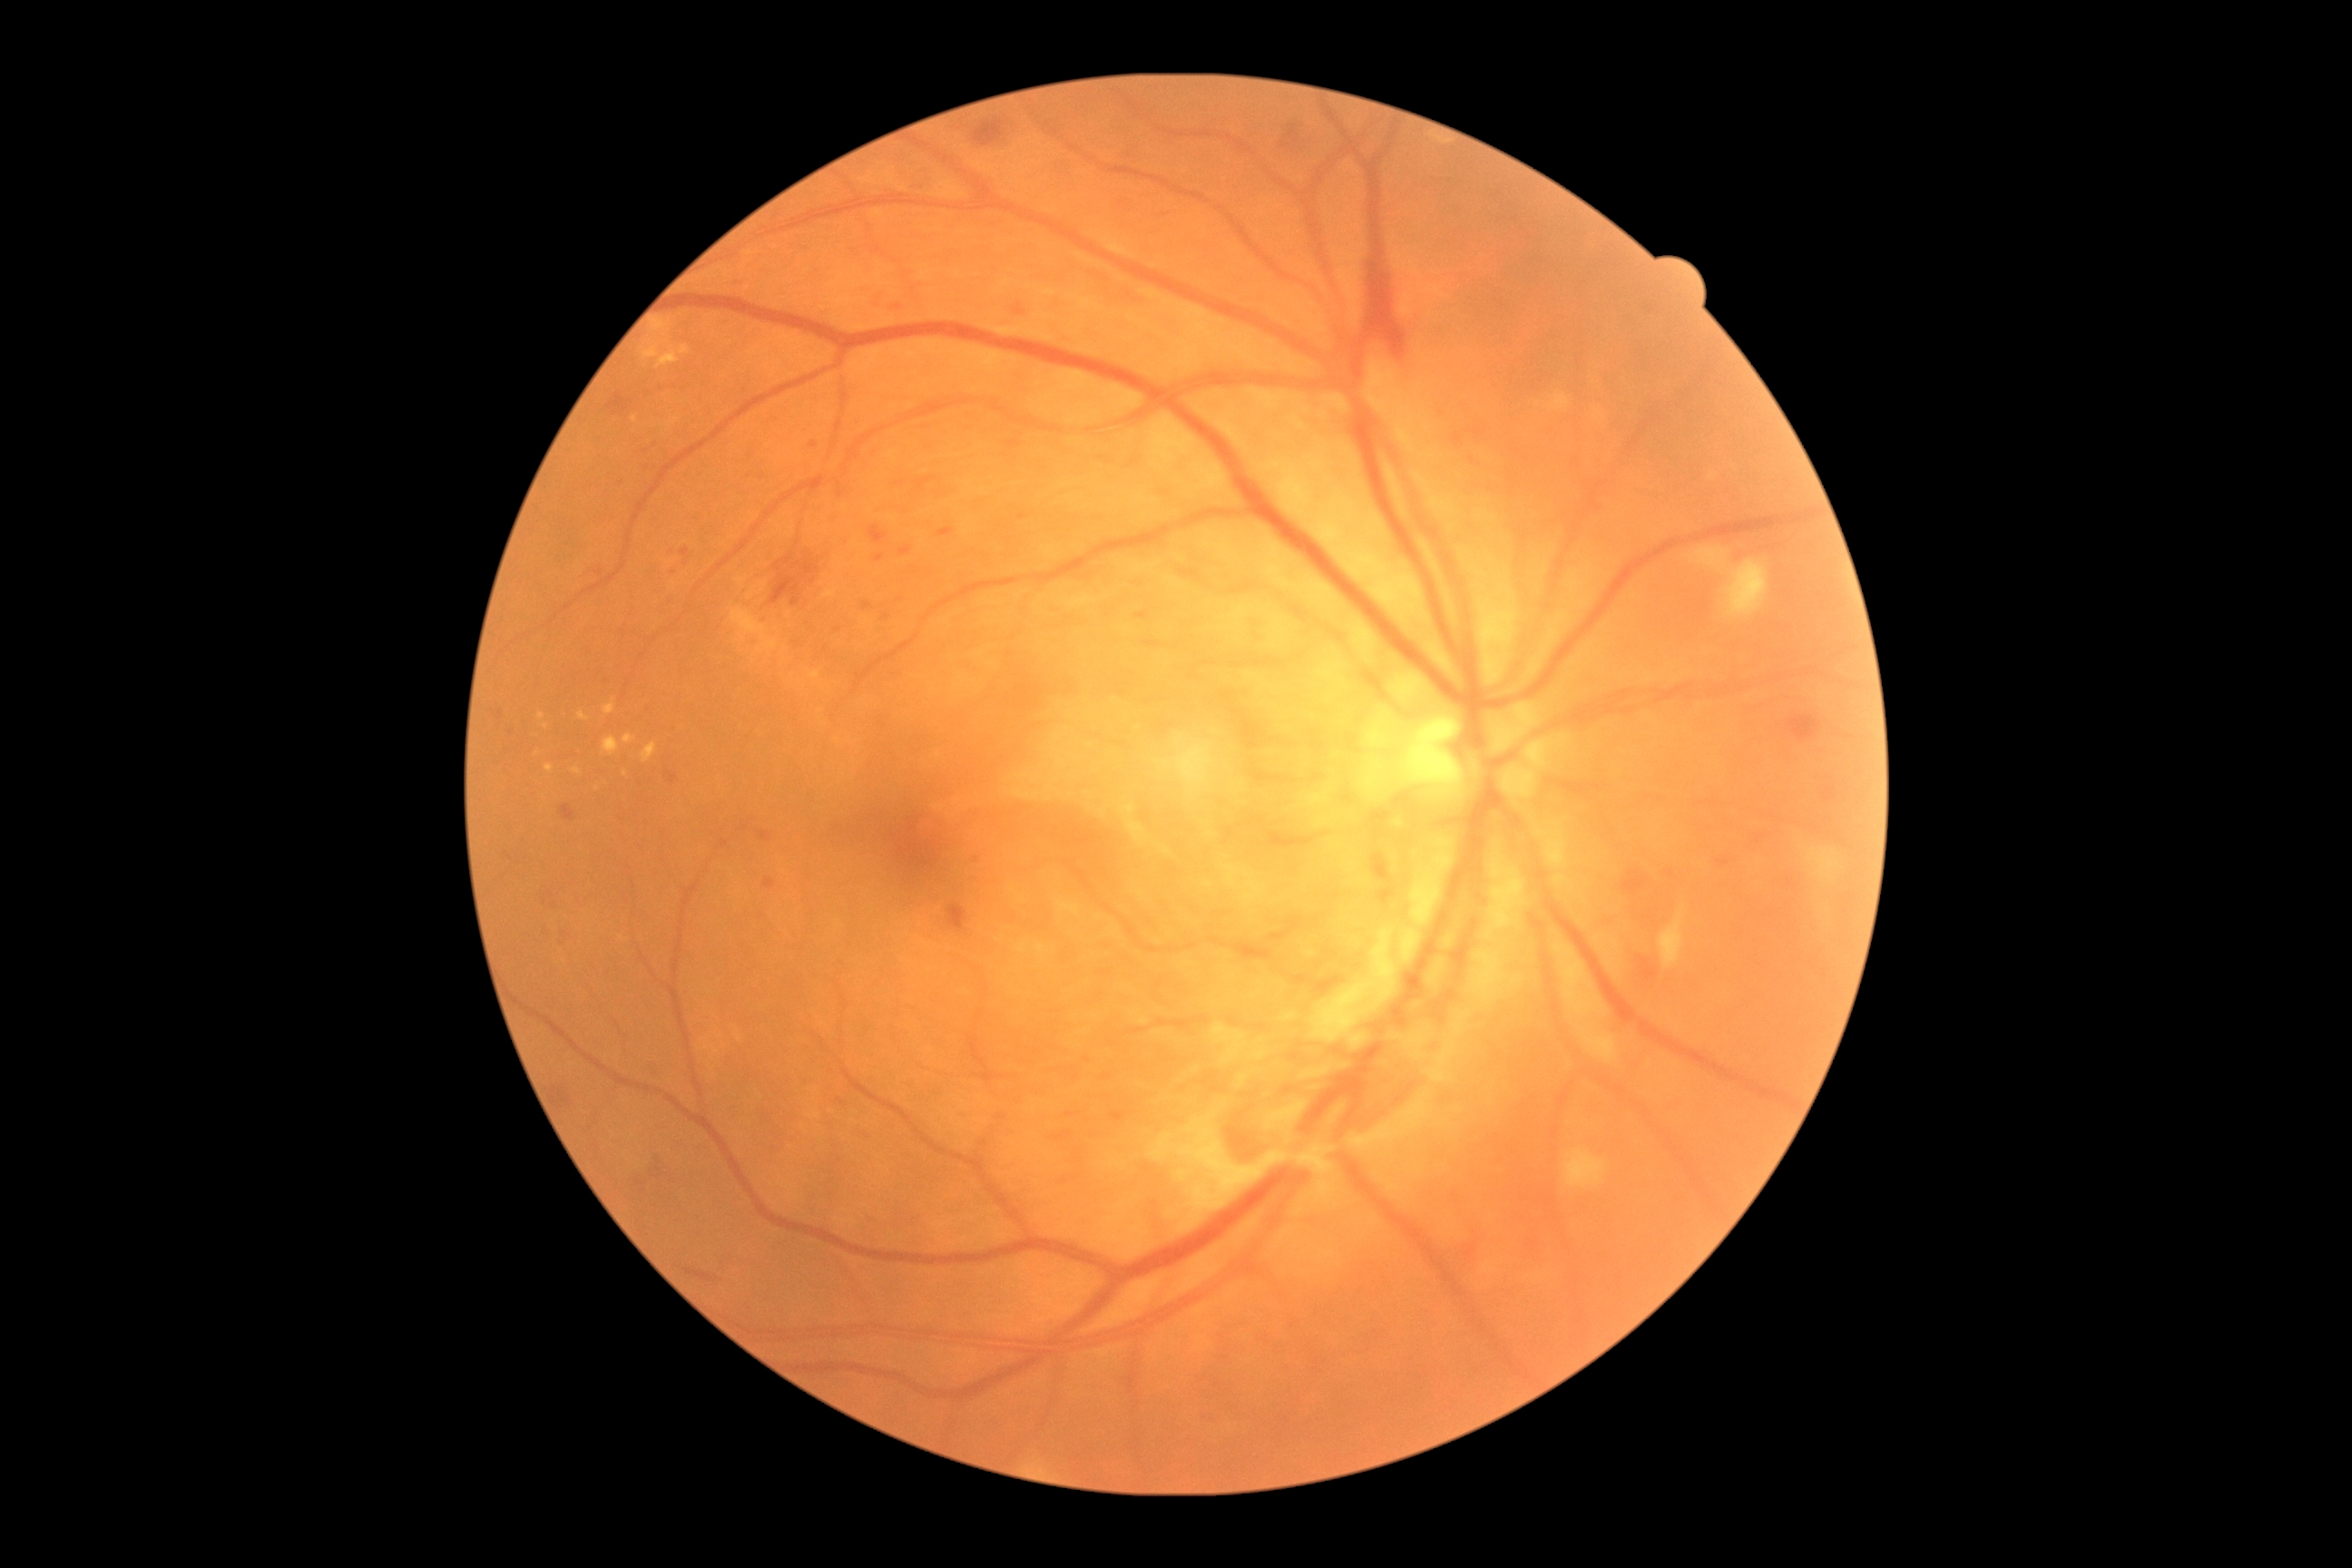

Diabetic retinopathy grade: 4 (PDR).
Soft exudates located at (1660,905,1685,968); (1565,1148,1607,1190); (1554,934,1607,1023); (1578,1023,1620,1064); (1723,560,1769,618); (1807,848,1839,881); (732,609,779,651).
Hemorrhages are present, including at (607,395,634,416); (1063,816,1112,852); (683,1268,720,1282); (1315,977,1342,995); (1366,273,1409,364); (1787,877,1798,890); (1378,890,1393,905); (946,903,968,936); (1462,1239,1480,1260); (1787,712,1823,743); (560,805,576,821); (1291,975,1313,986); (665,770,678,783).
Microaneurysms are present, including at (899,547,912,556); (883,614,890,622); (1017,306,1024,317); (1754,836,1769,845); (1135,612,1150,622); (1066,1112,1079,1119); (1220,691,1275,752); (937,527,954,538); (836,1099,847,1106).
Smaller microaneurysms around [639,1182]; [511,732]; [1472,461]; [644,1191]; [898,307]; [555,905]; [841,1160].
Hard exudates are present, including at (605,700,616,716); (573,769,582,776); (652,318,672,331); (680,346,691,355); (623,734,636,745); (643,348,660,360); (538,714,547,721); (603,736,620,756); (623,770,629,778); (578,712,589,721); (658,351,678,369); (642,743,658,763); (545,765,554,772).
Smaller hard exudates around [545,726]; [537,755].